640x480px. Pediatric wide-field fundus photograph. Acquired on the Clarity RetCam 3: 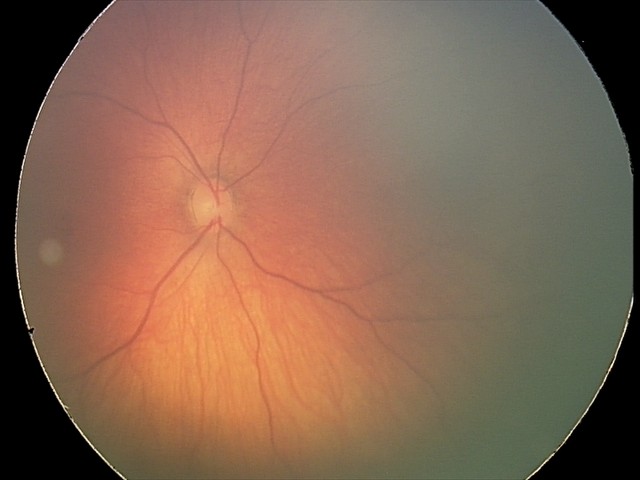

Q: What is the screening diagnosis?
A: retinal hemorrhages